Color fundus image · 45° FOV:
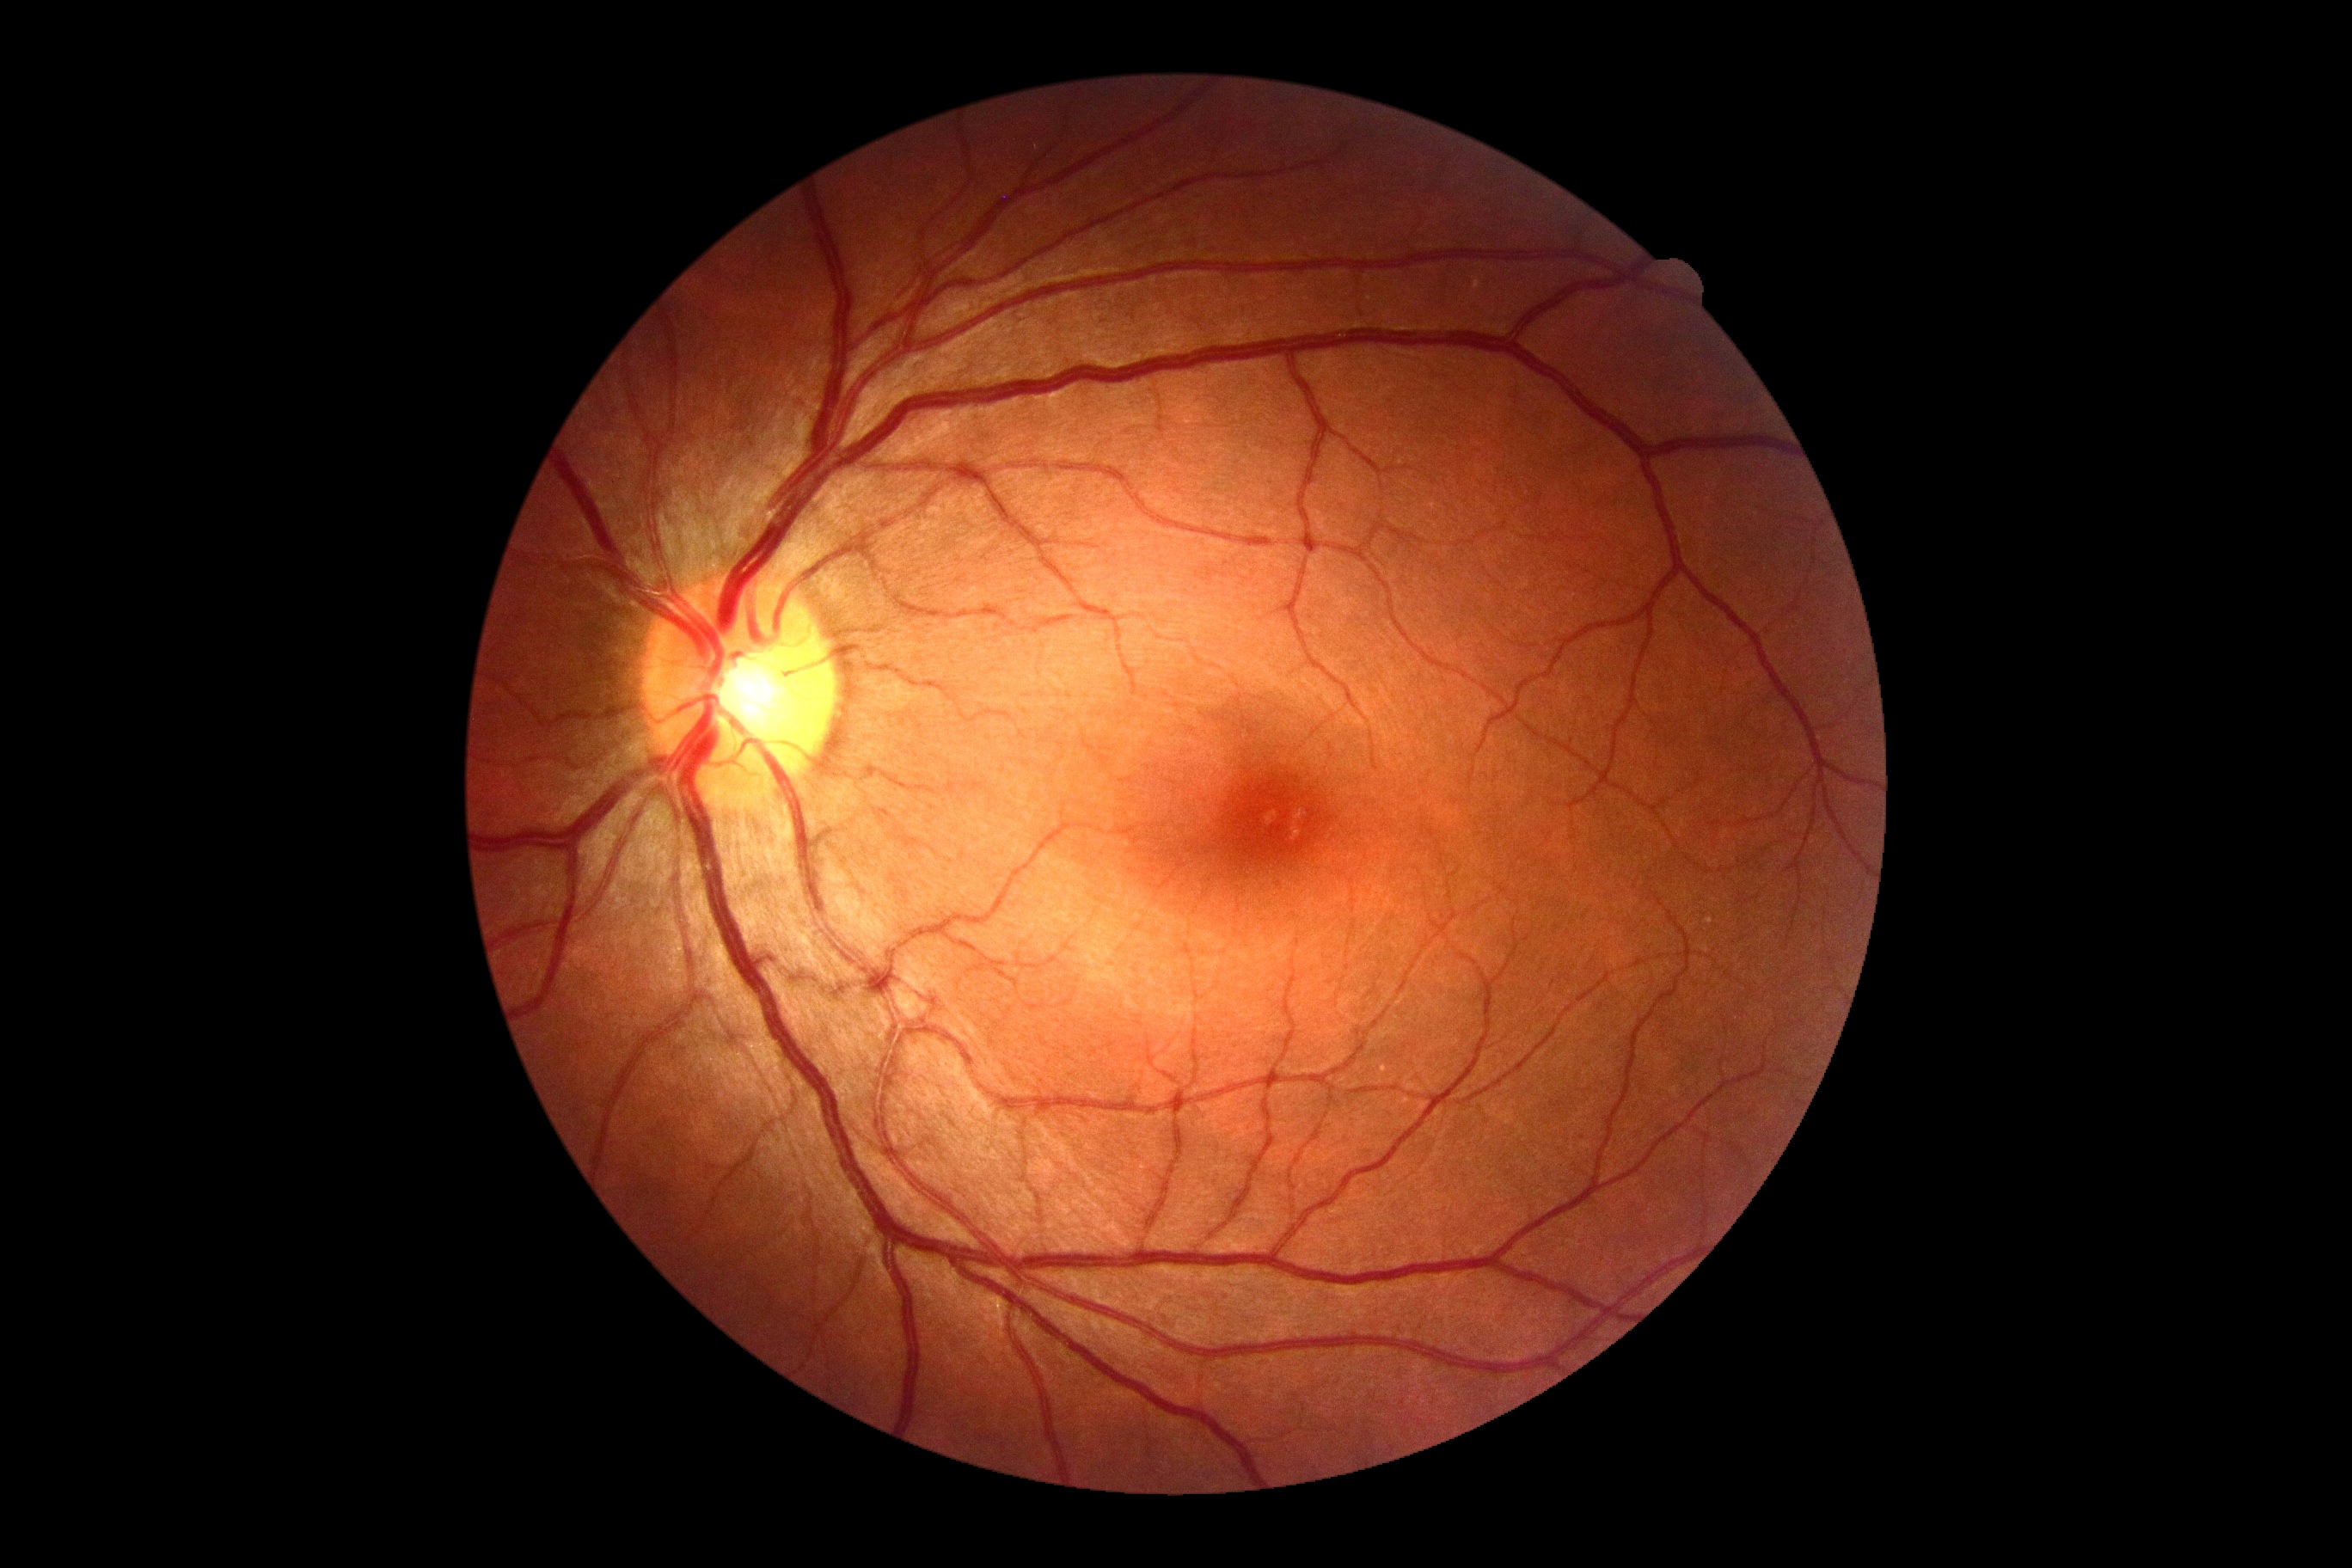

DR severity: grade 0 (no apparent retinopathy).